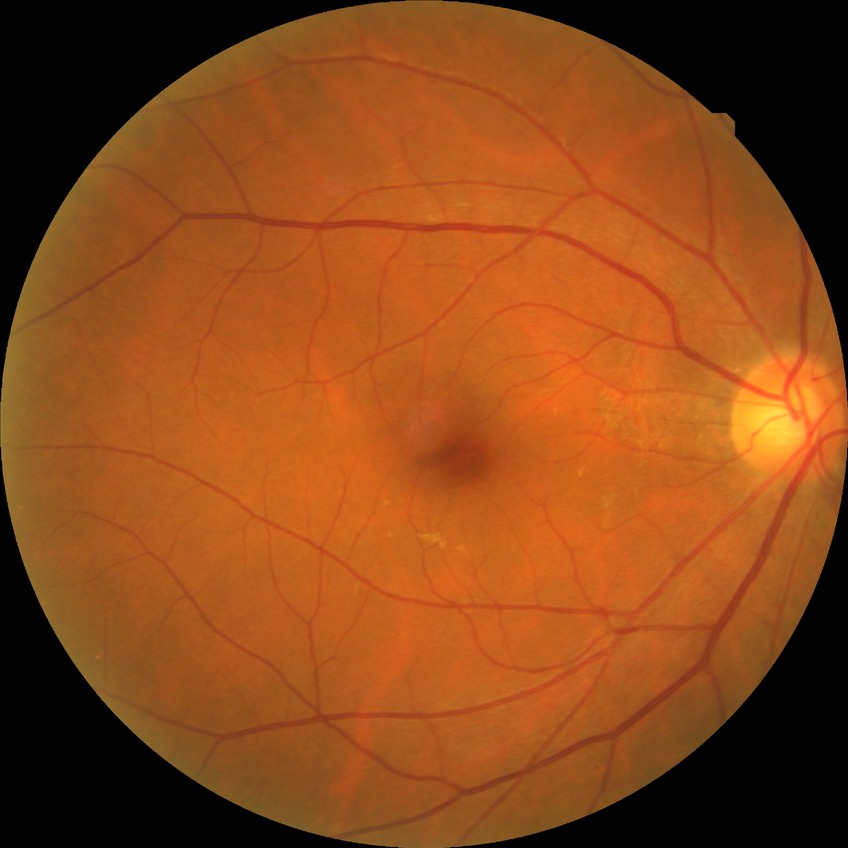 Diabetic retinopathy (DR): no diabetic retinopathy (NDR).